Captured on a Topcon TRC-NW8 fundus camera.
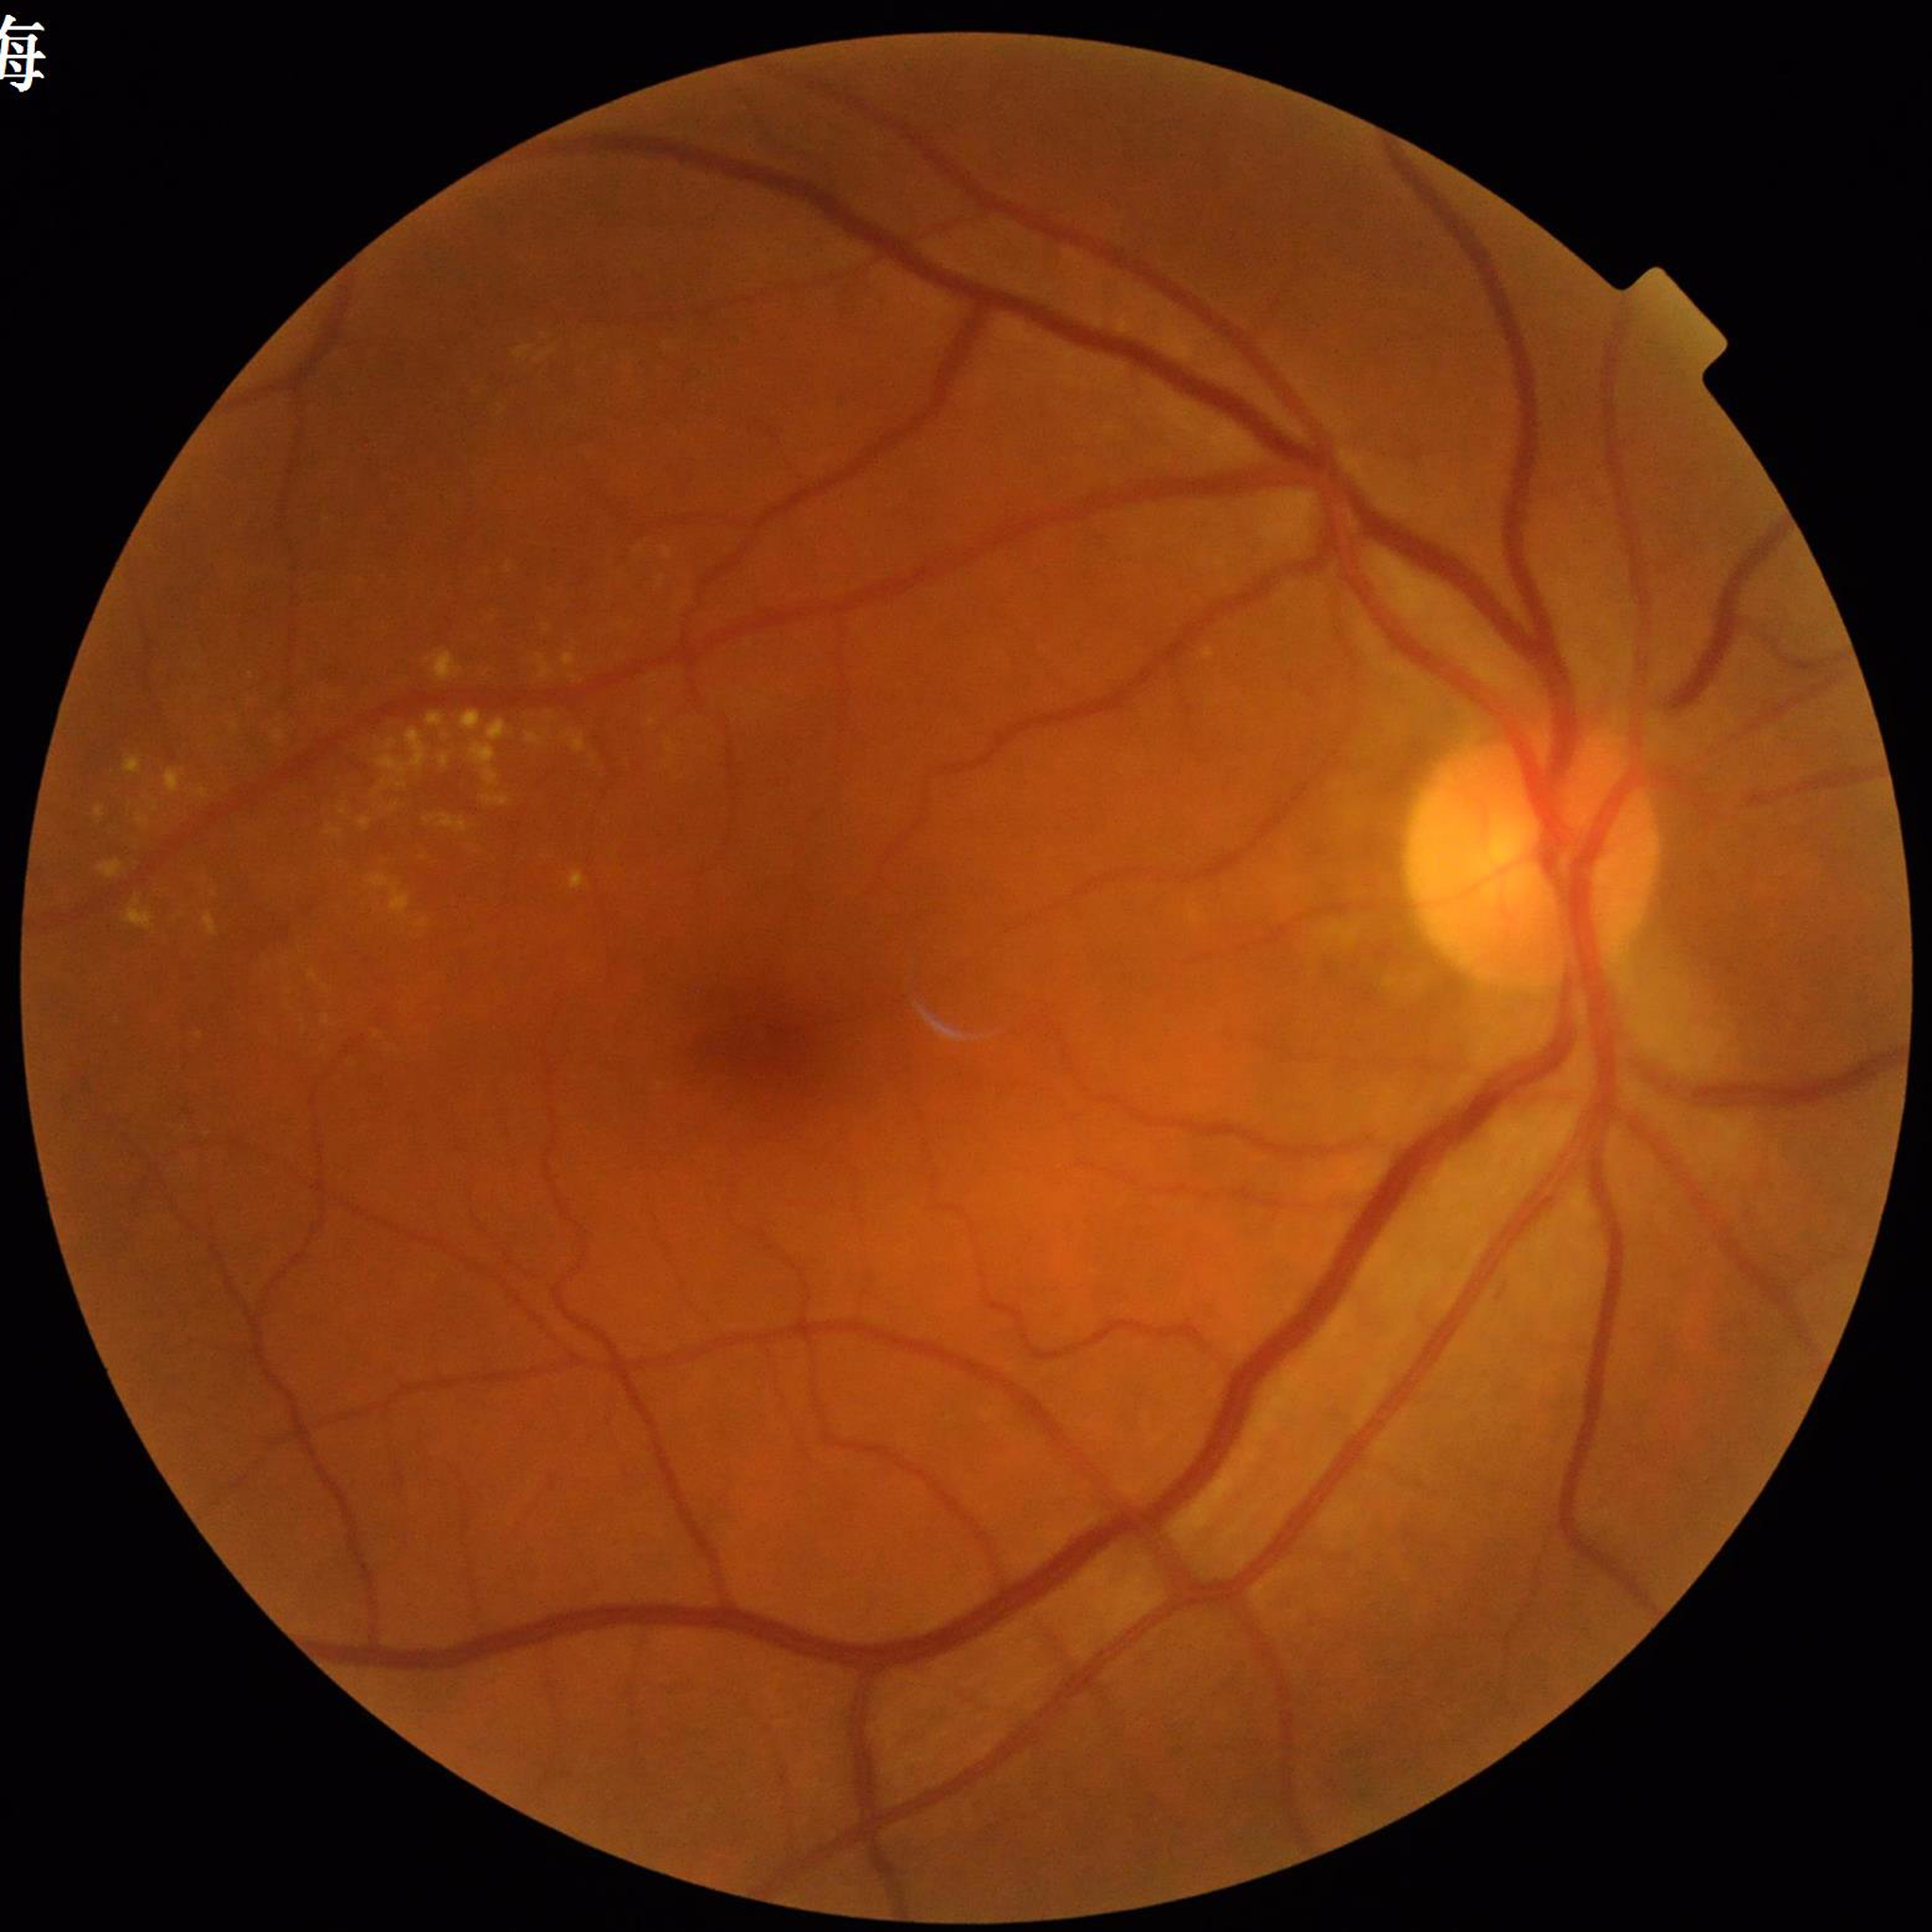

Clinical diagnosis: diabetic retinopathy (DR).